Captured on a Remidio smartphone fundus camera.
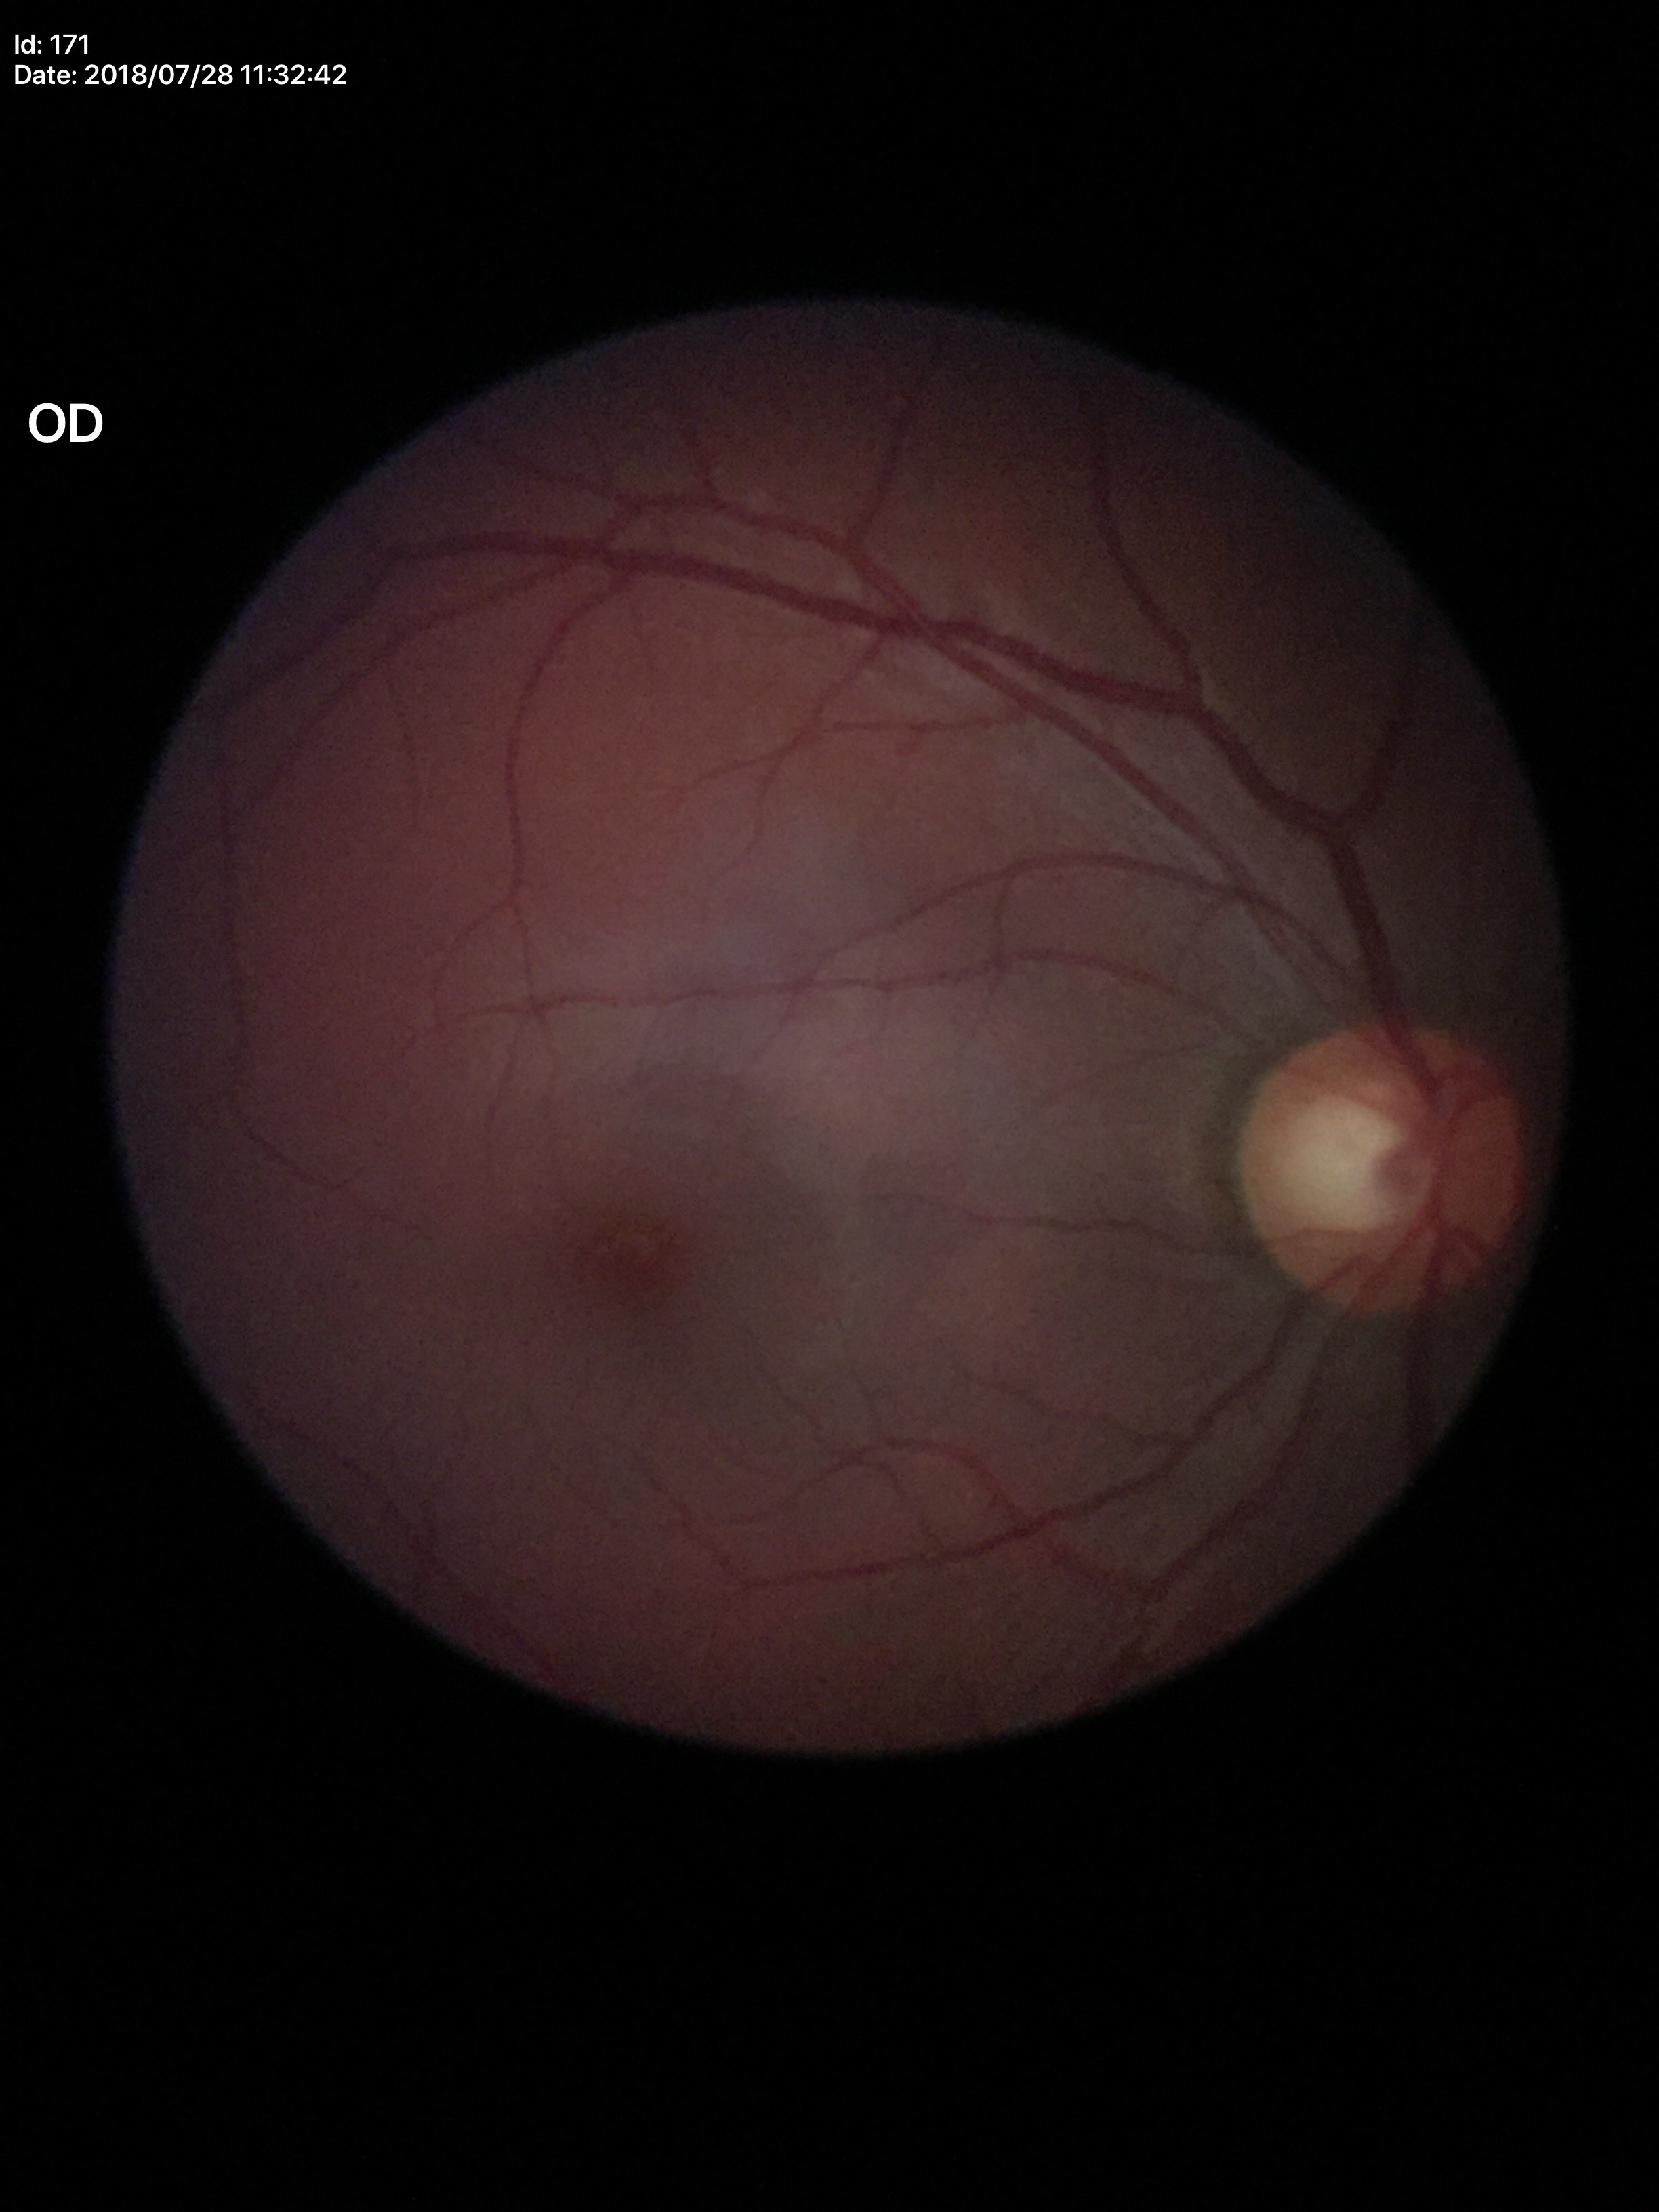
Findings:
• Glaucoma assessment: no suspicious findings (two of five ophthalmologists flagged glaucoma suspect)
• vertical cup-disc ratio: 0.58
• horizontal CDR: 0.59